848 x 848 pixels
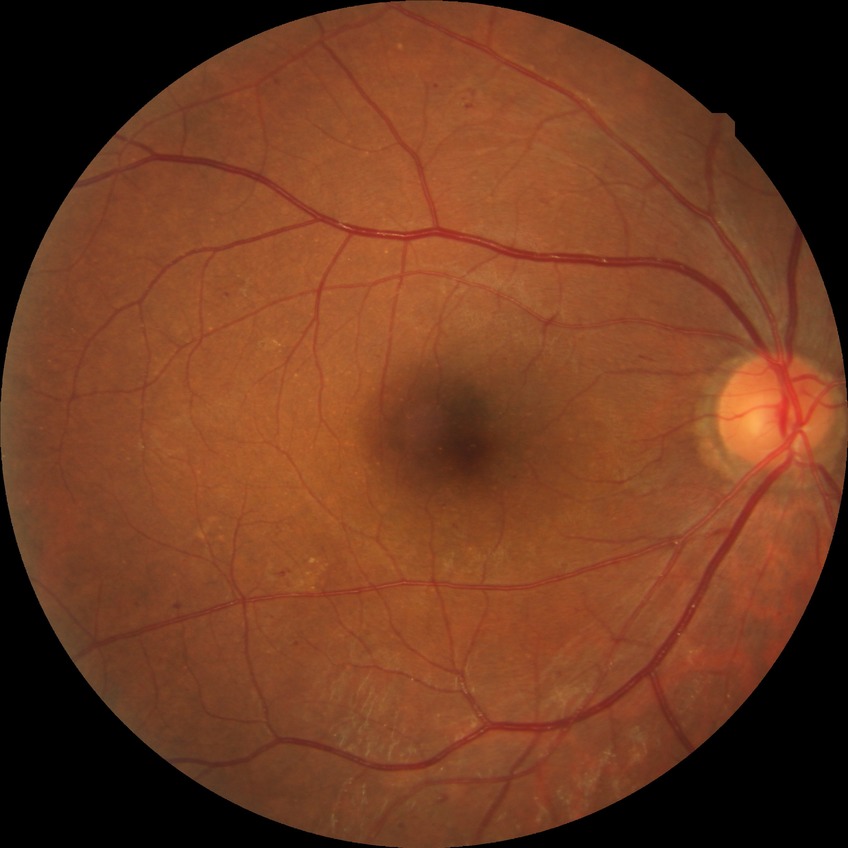

davis_grade: SDR (simple diabetic retinopathy)